Fundus photo taken with a portable handheld camera.
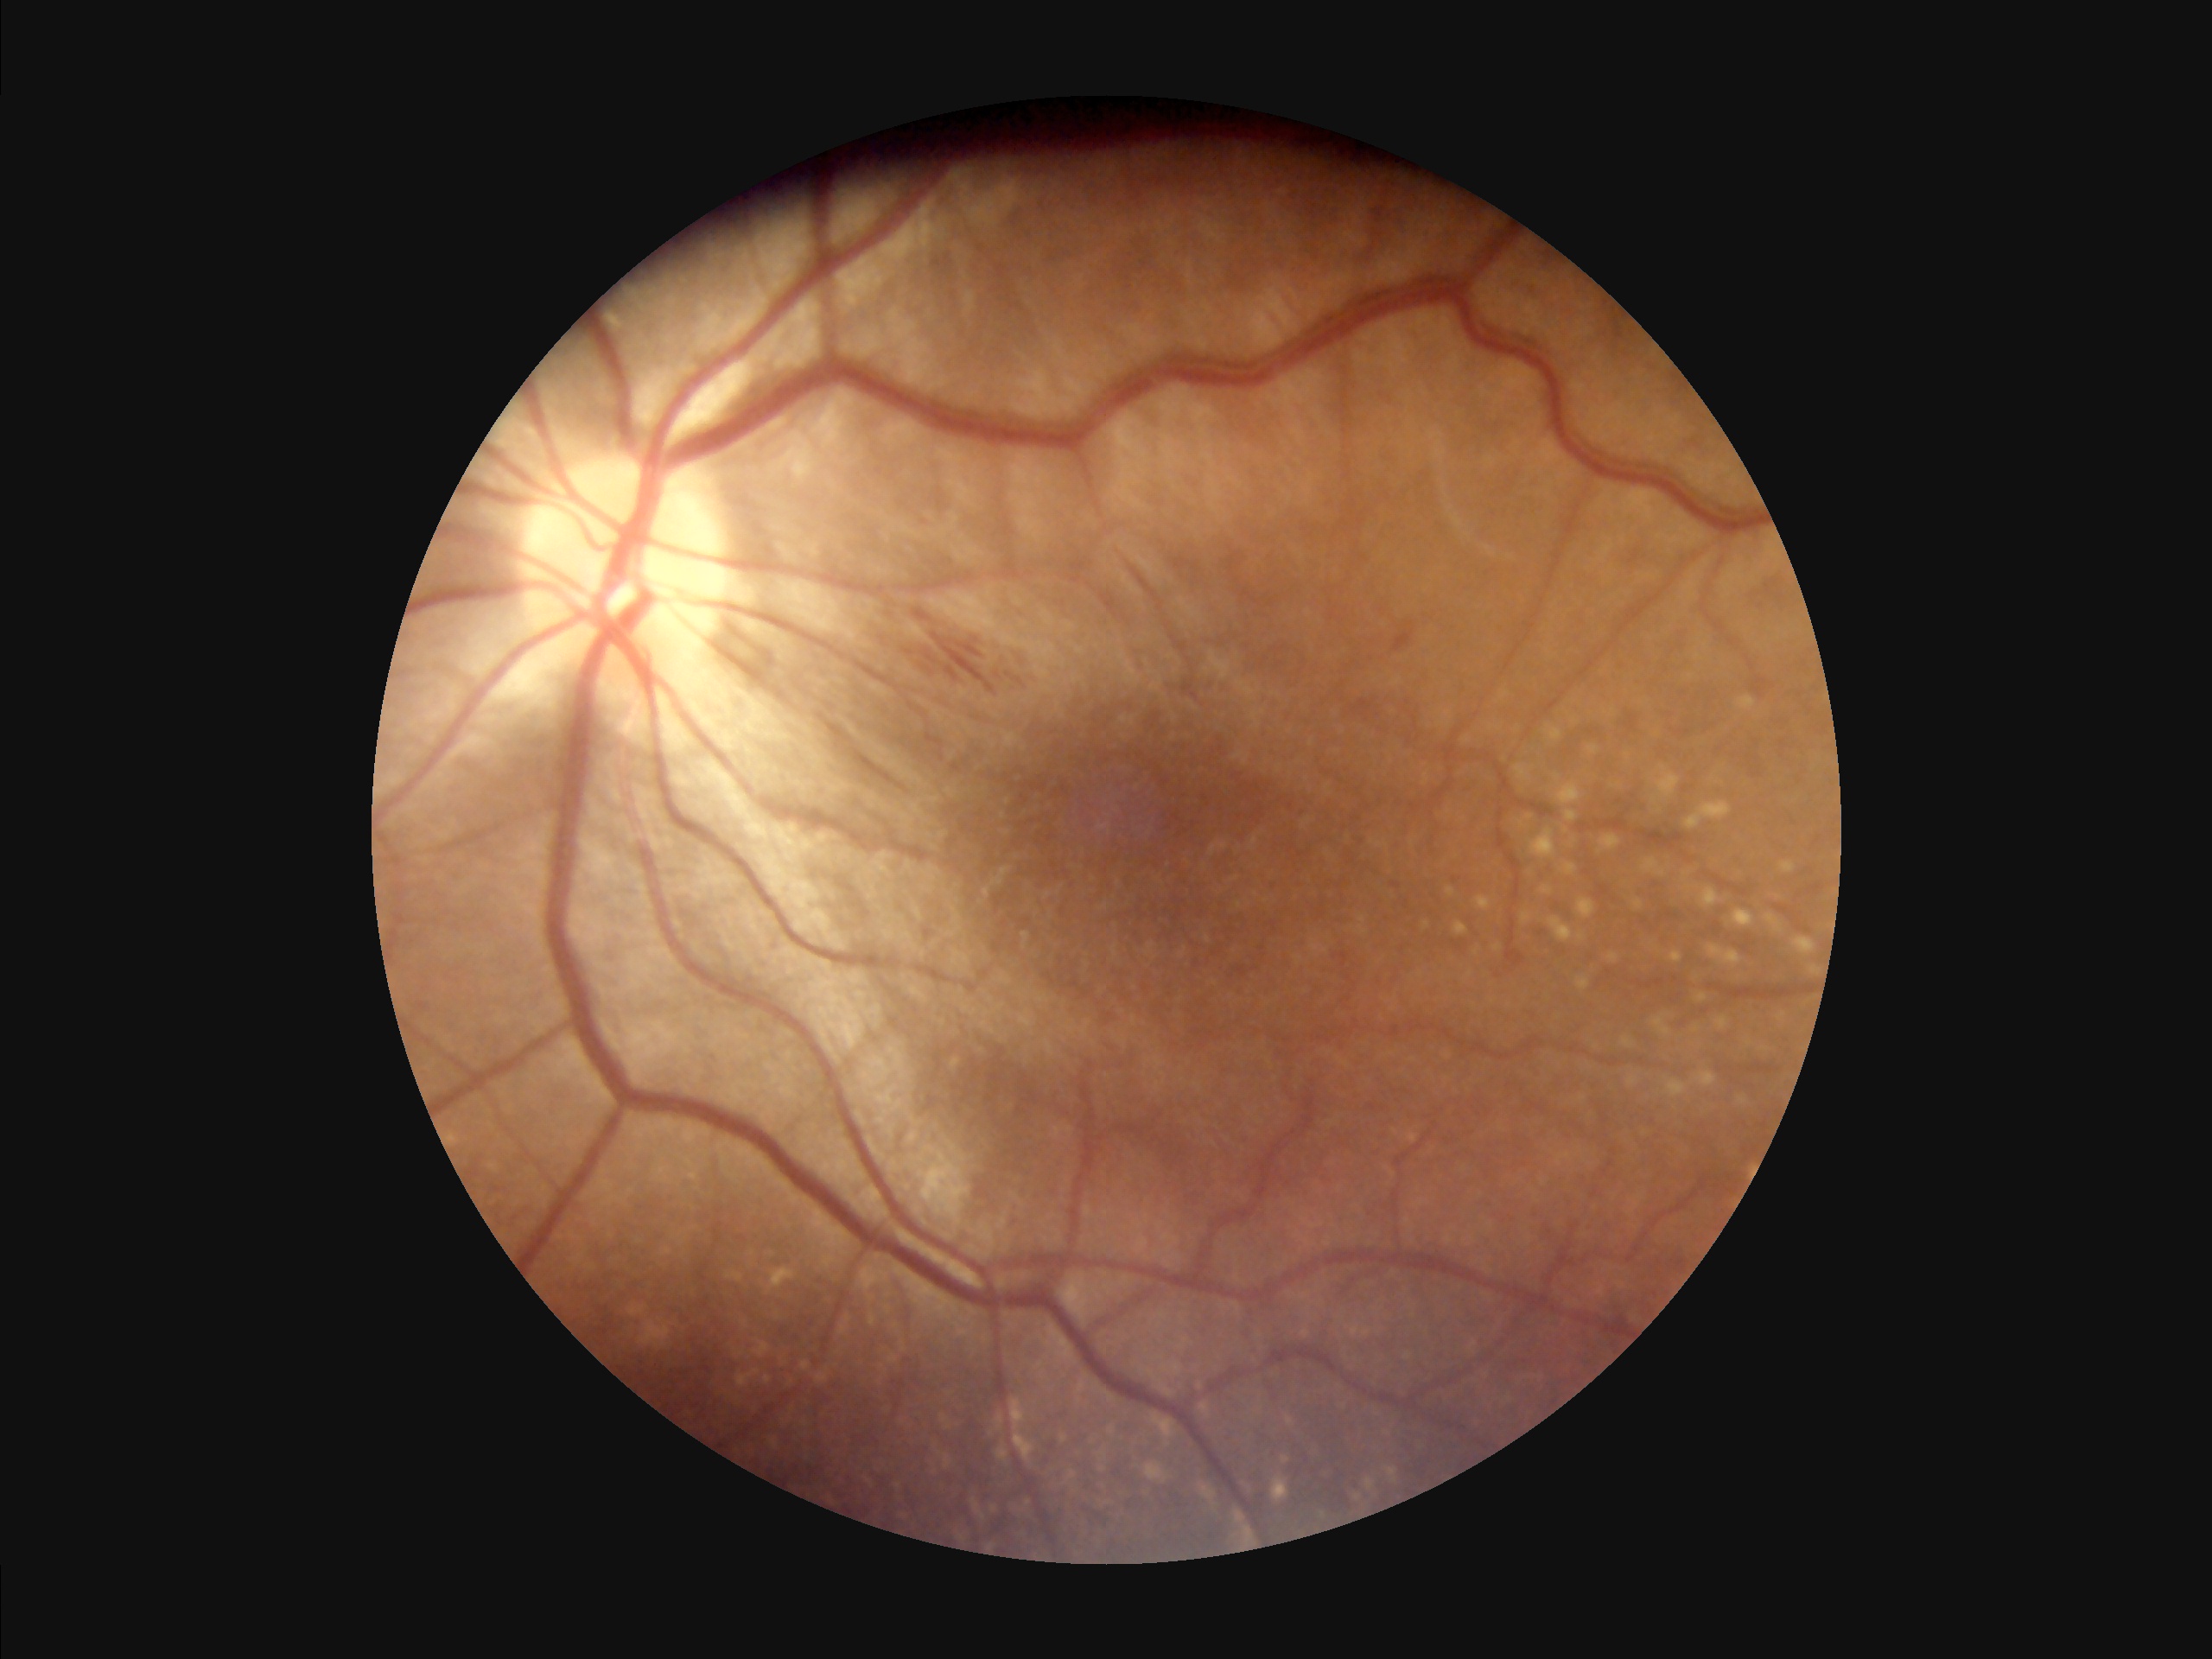

{"illumination": "satisfactory", "contrast": "good", "overall_quality": "adequate"}